Pediatric retinal photograph (wide-field) · camera: Phoenix ICON (100° FOV) · 1240 by 1240 pixels — 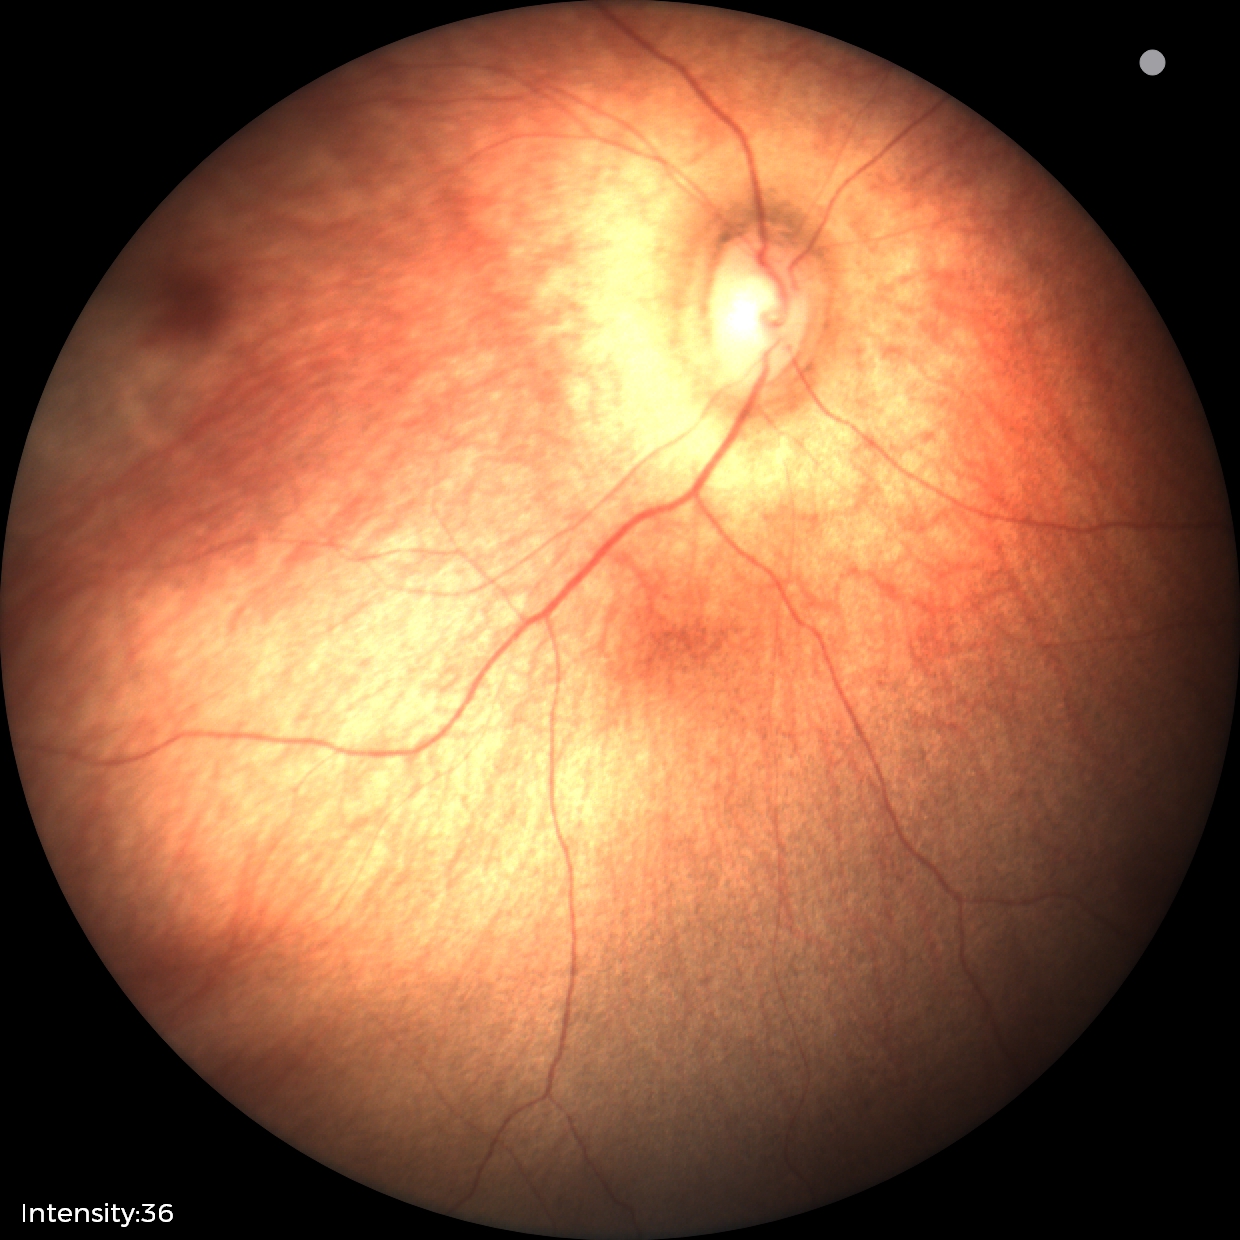
Impression: normal fundus examination.